Color fundus photograph, image size 848x848, diabetic retinopathy graded by the modified Davis classification, camera: NIDEK AFC-230, without pupil dilation.
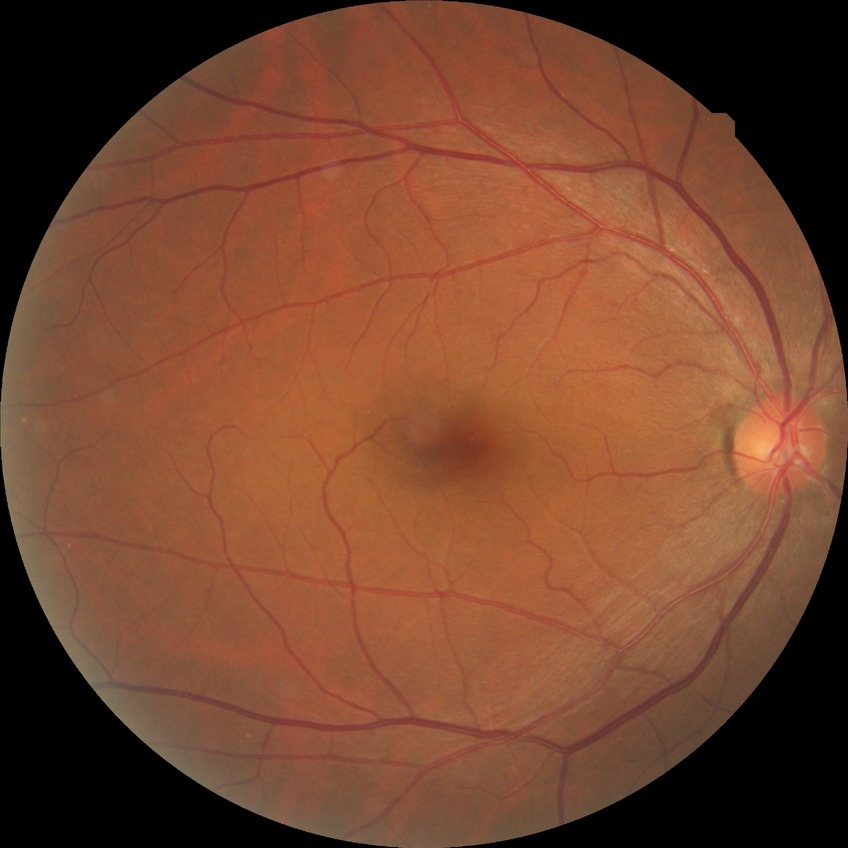
Diabetic retinopathy (DR) is no diabetic retinopathy (NDR).